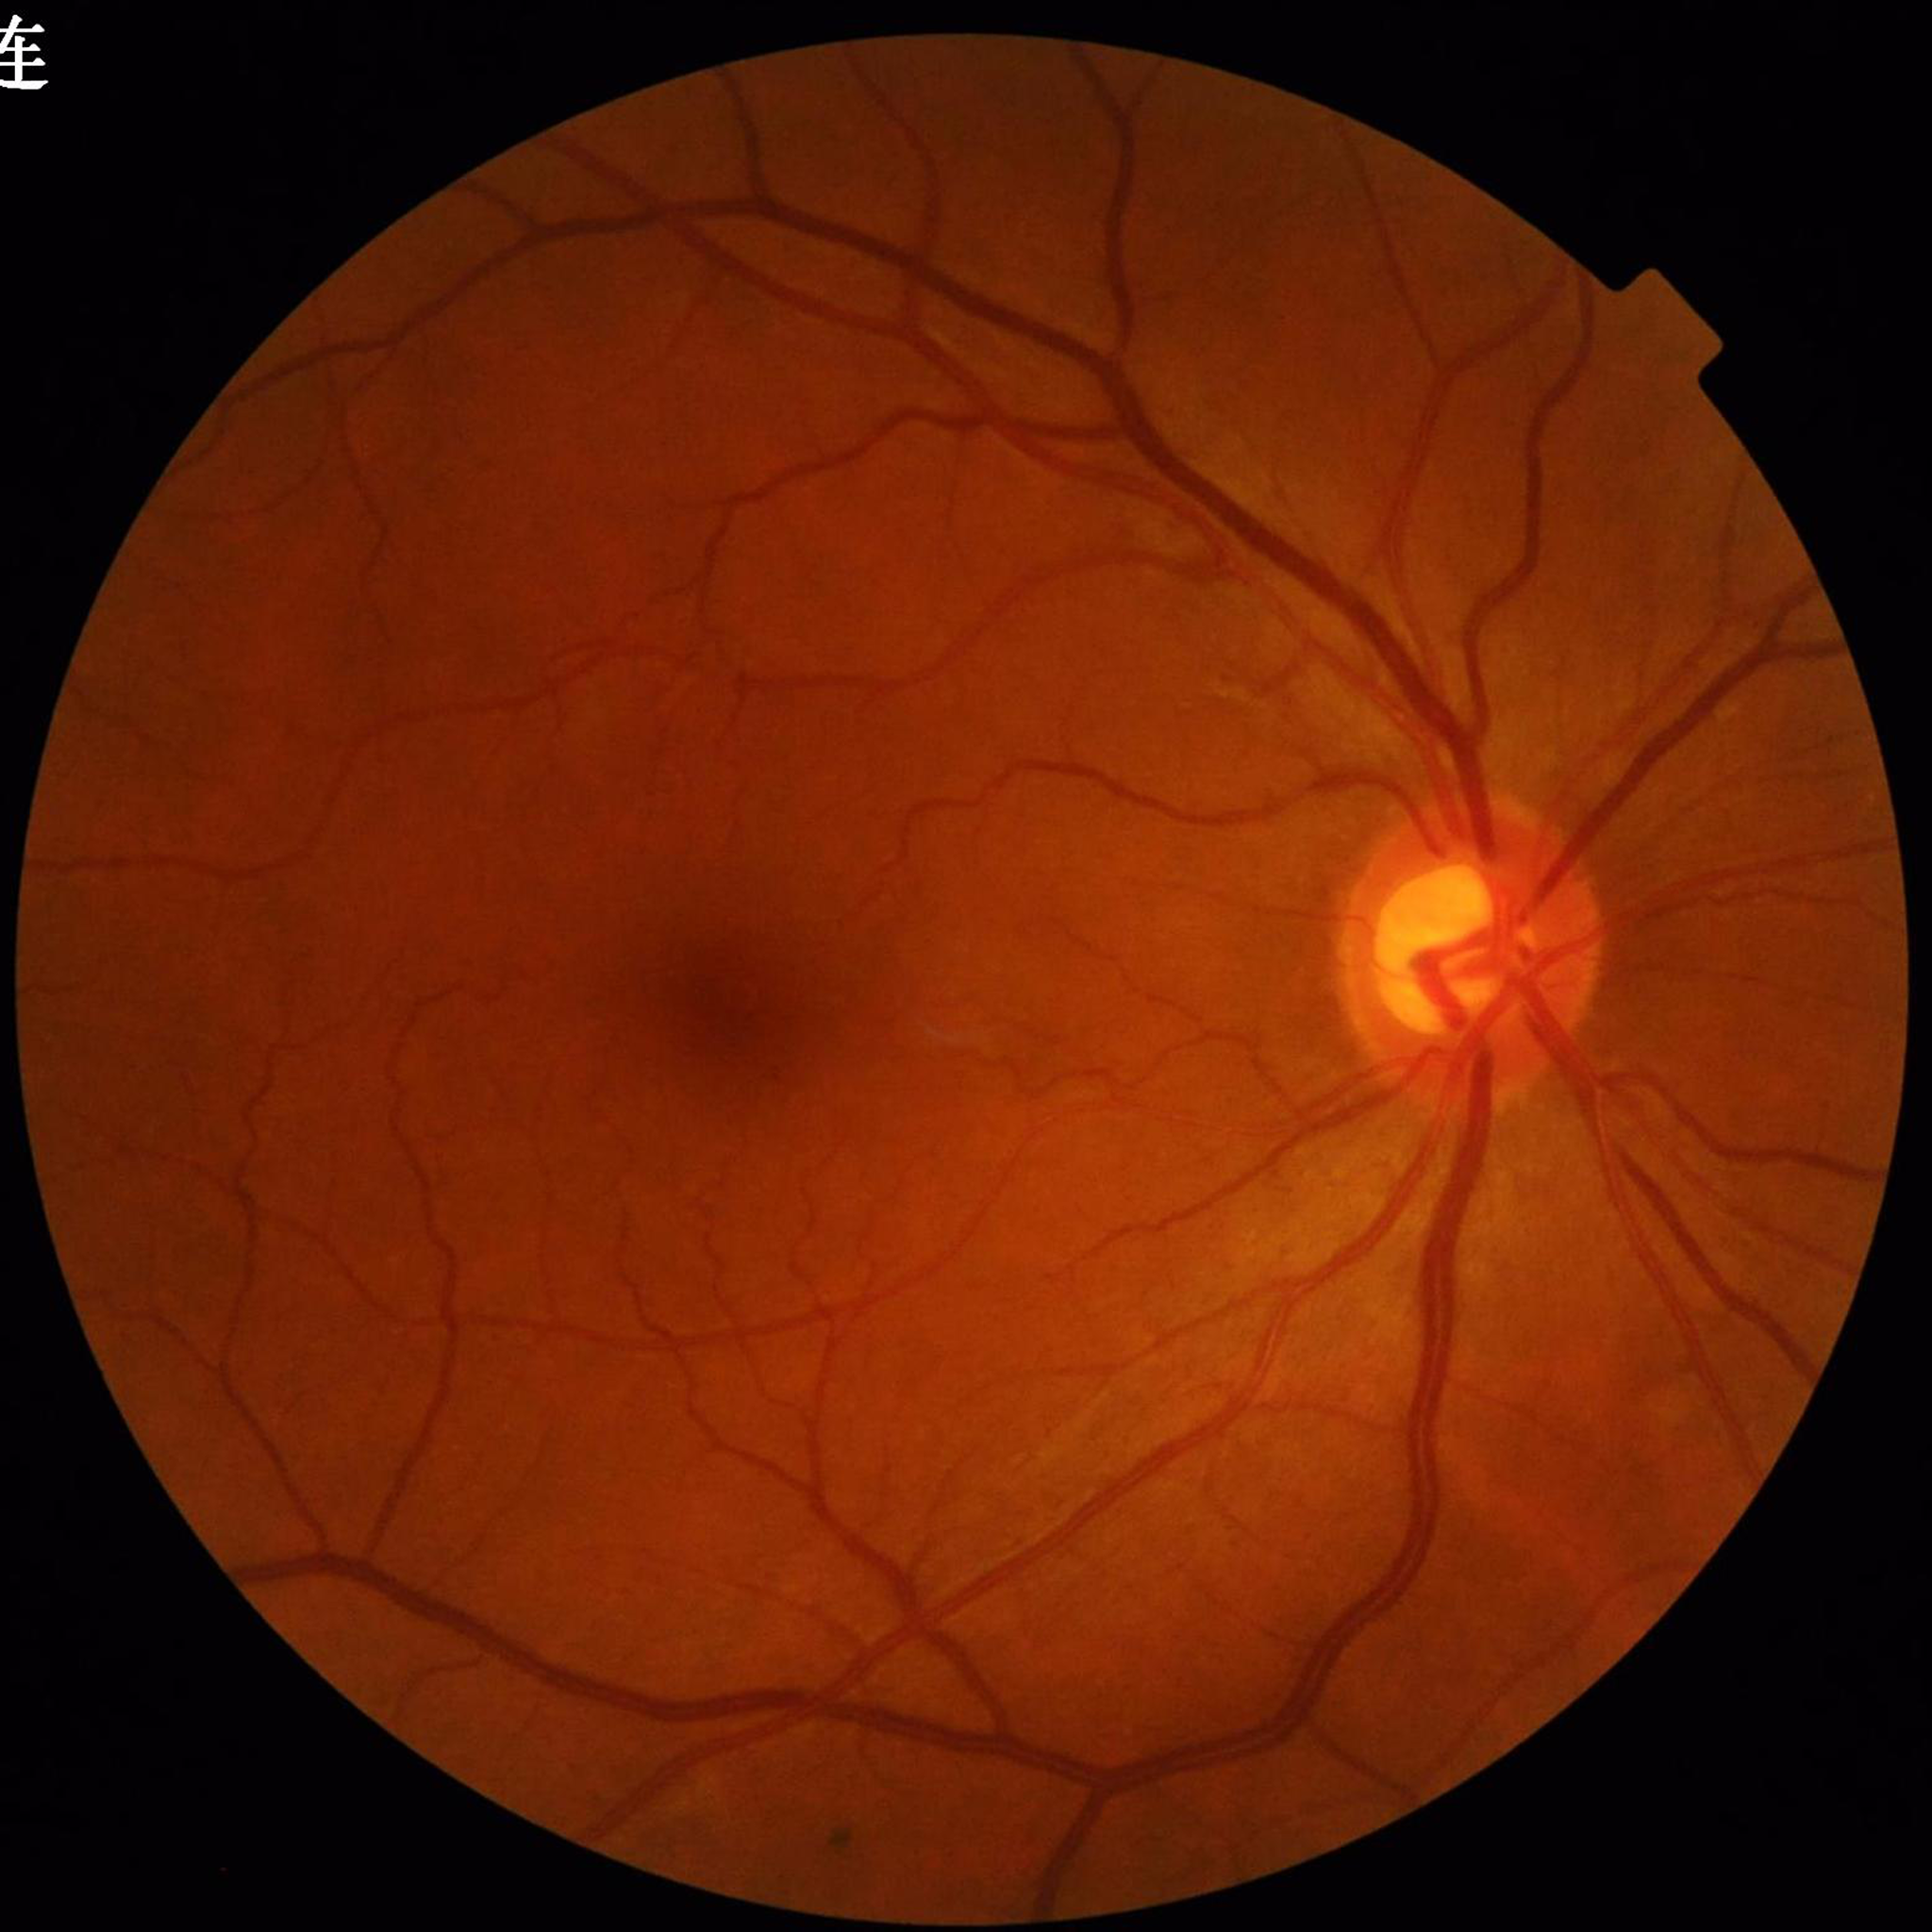

Color fundus photograph from a patient diagnosed with glaucoma.